Graded on the modified Davis scale; nonmydriatic fundus photograph
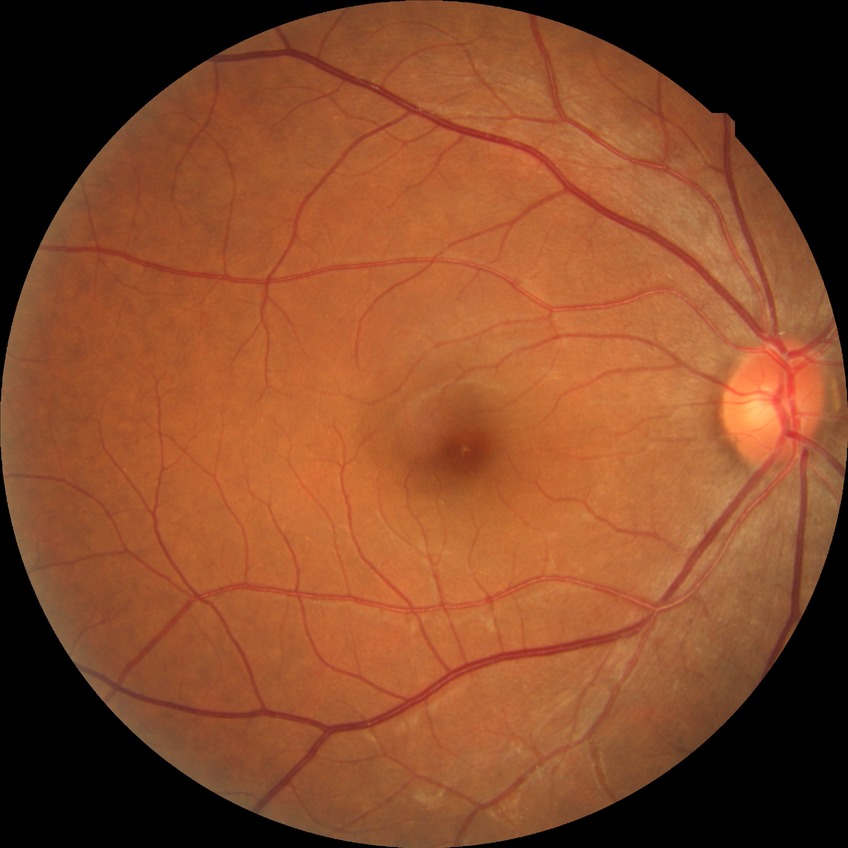
  davis_grade: no diabetic retinopathy (NDR)